Fundus photo. 2048x1536. FOV: 45 degrees — 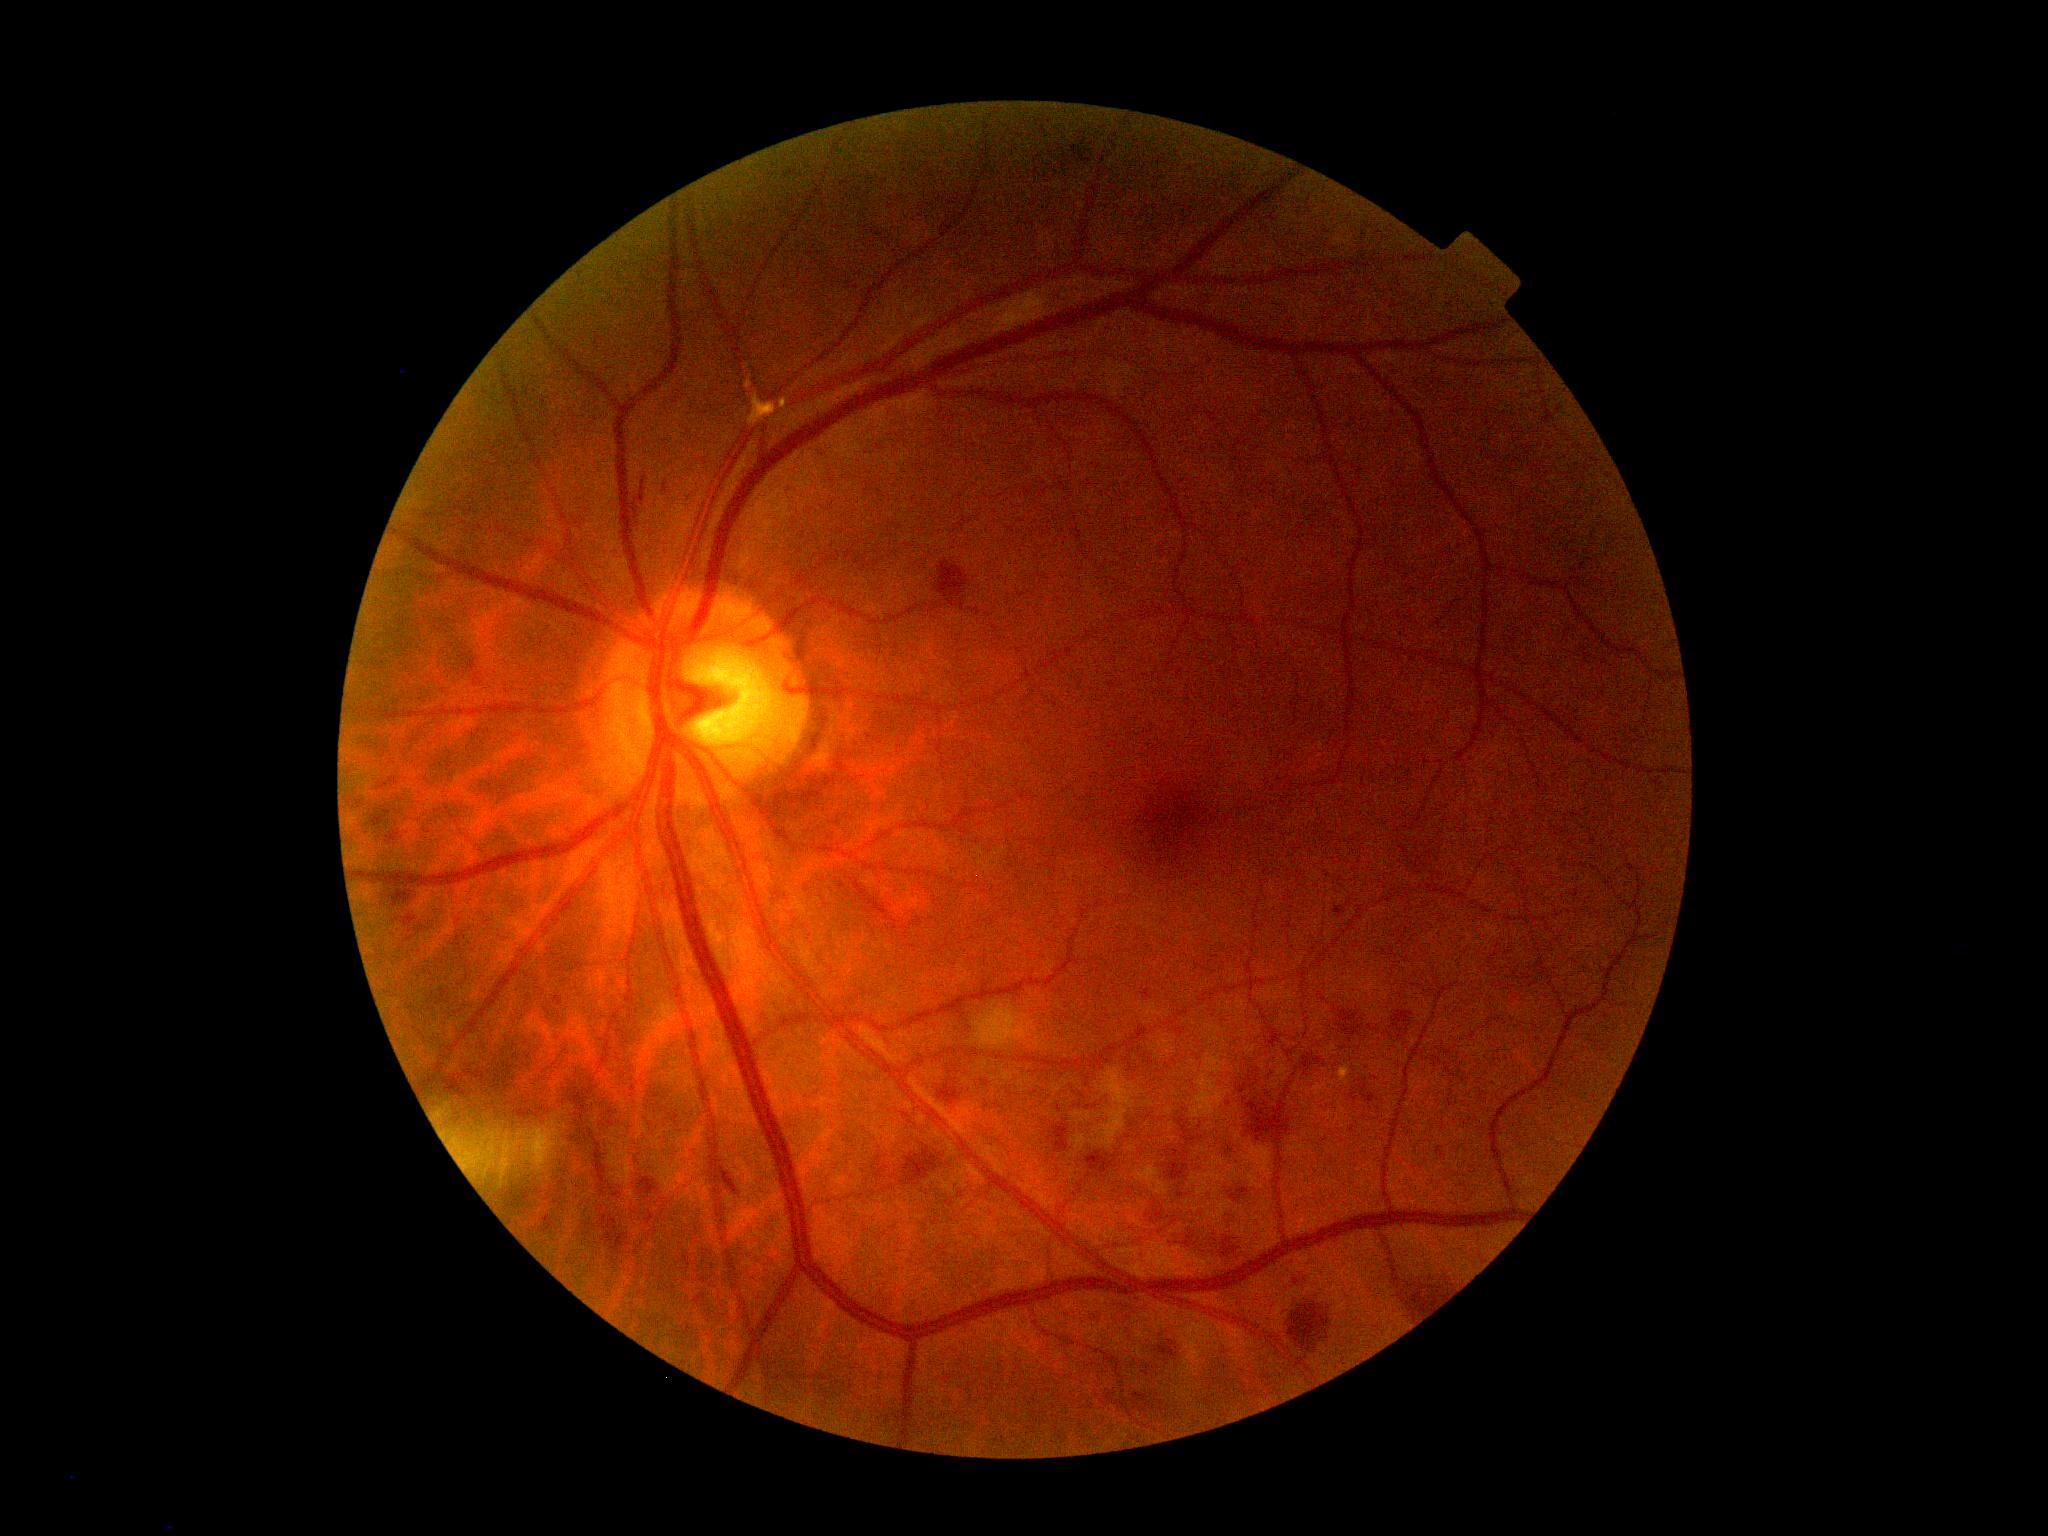   dr_category: non-proliferative diabetic retinopathy
  dr_grade: moderate non-proliferative diabetic retinopathy (grade 2)